1504 by 1000 pixels, fundus photo.
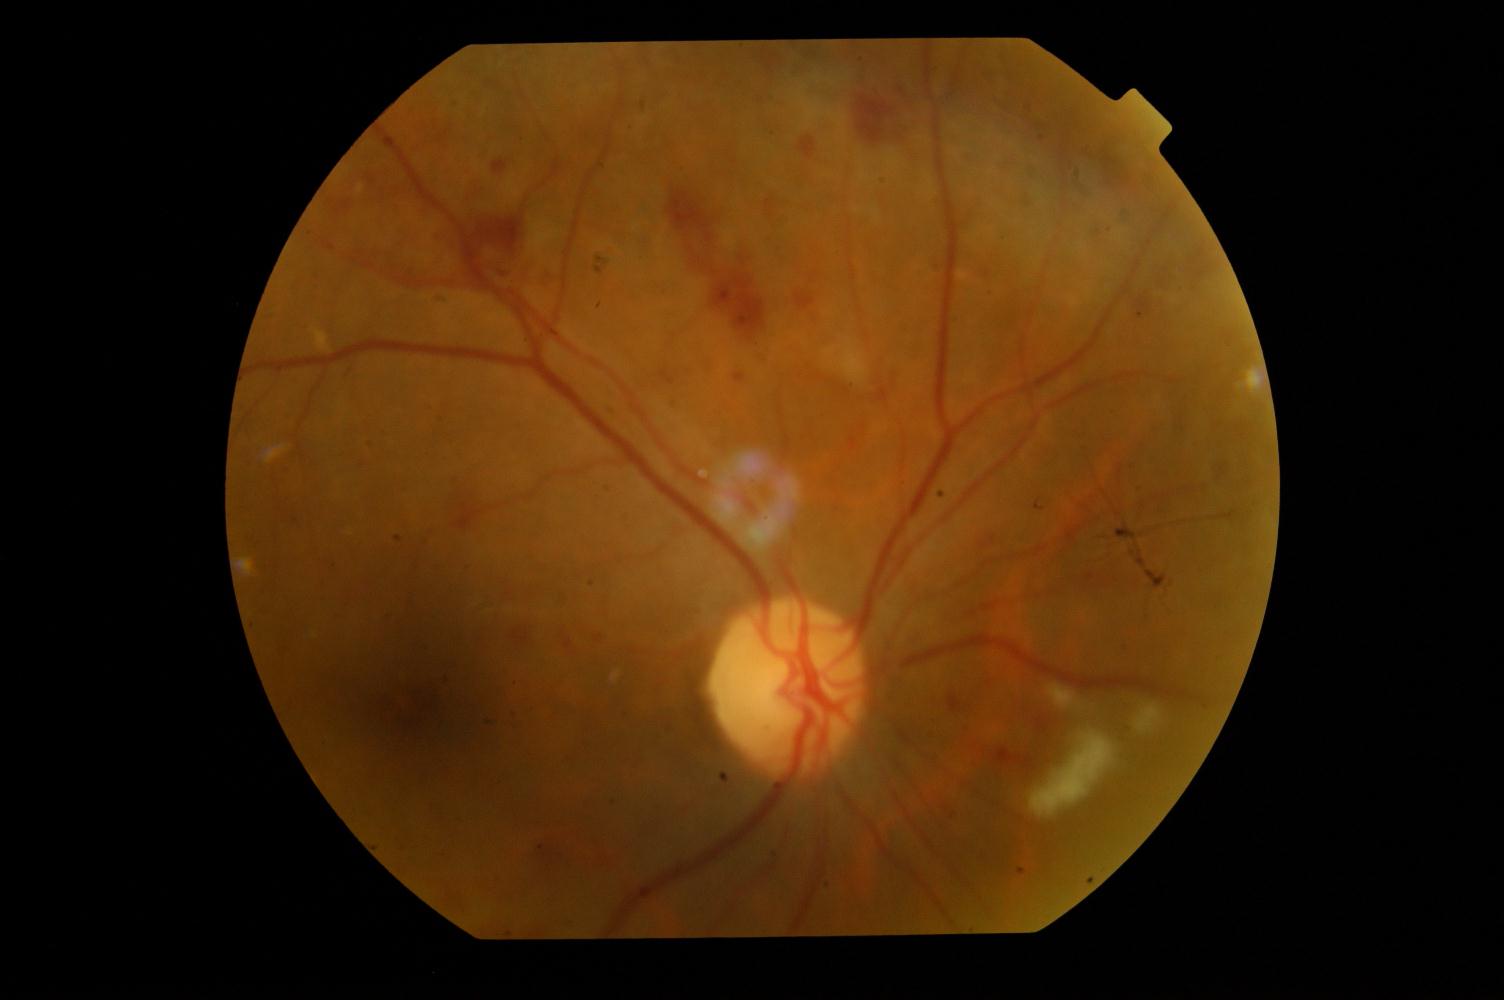
Findings consistent with diabetic retinopathy.